Image size 1659x2212, CFP.
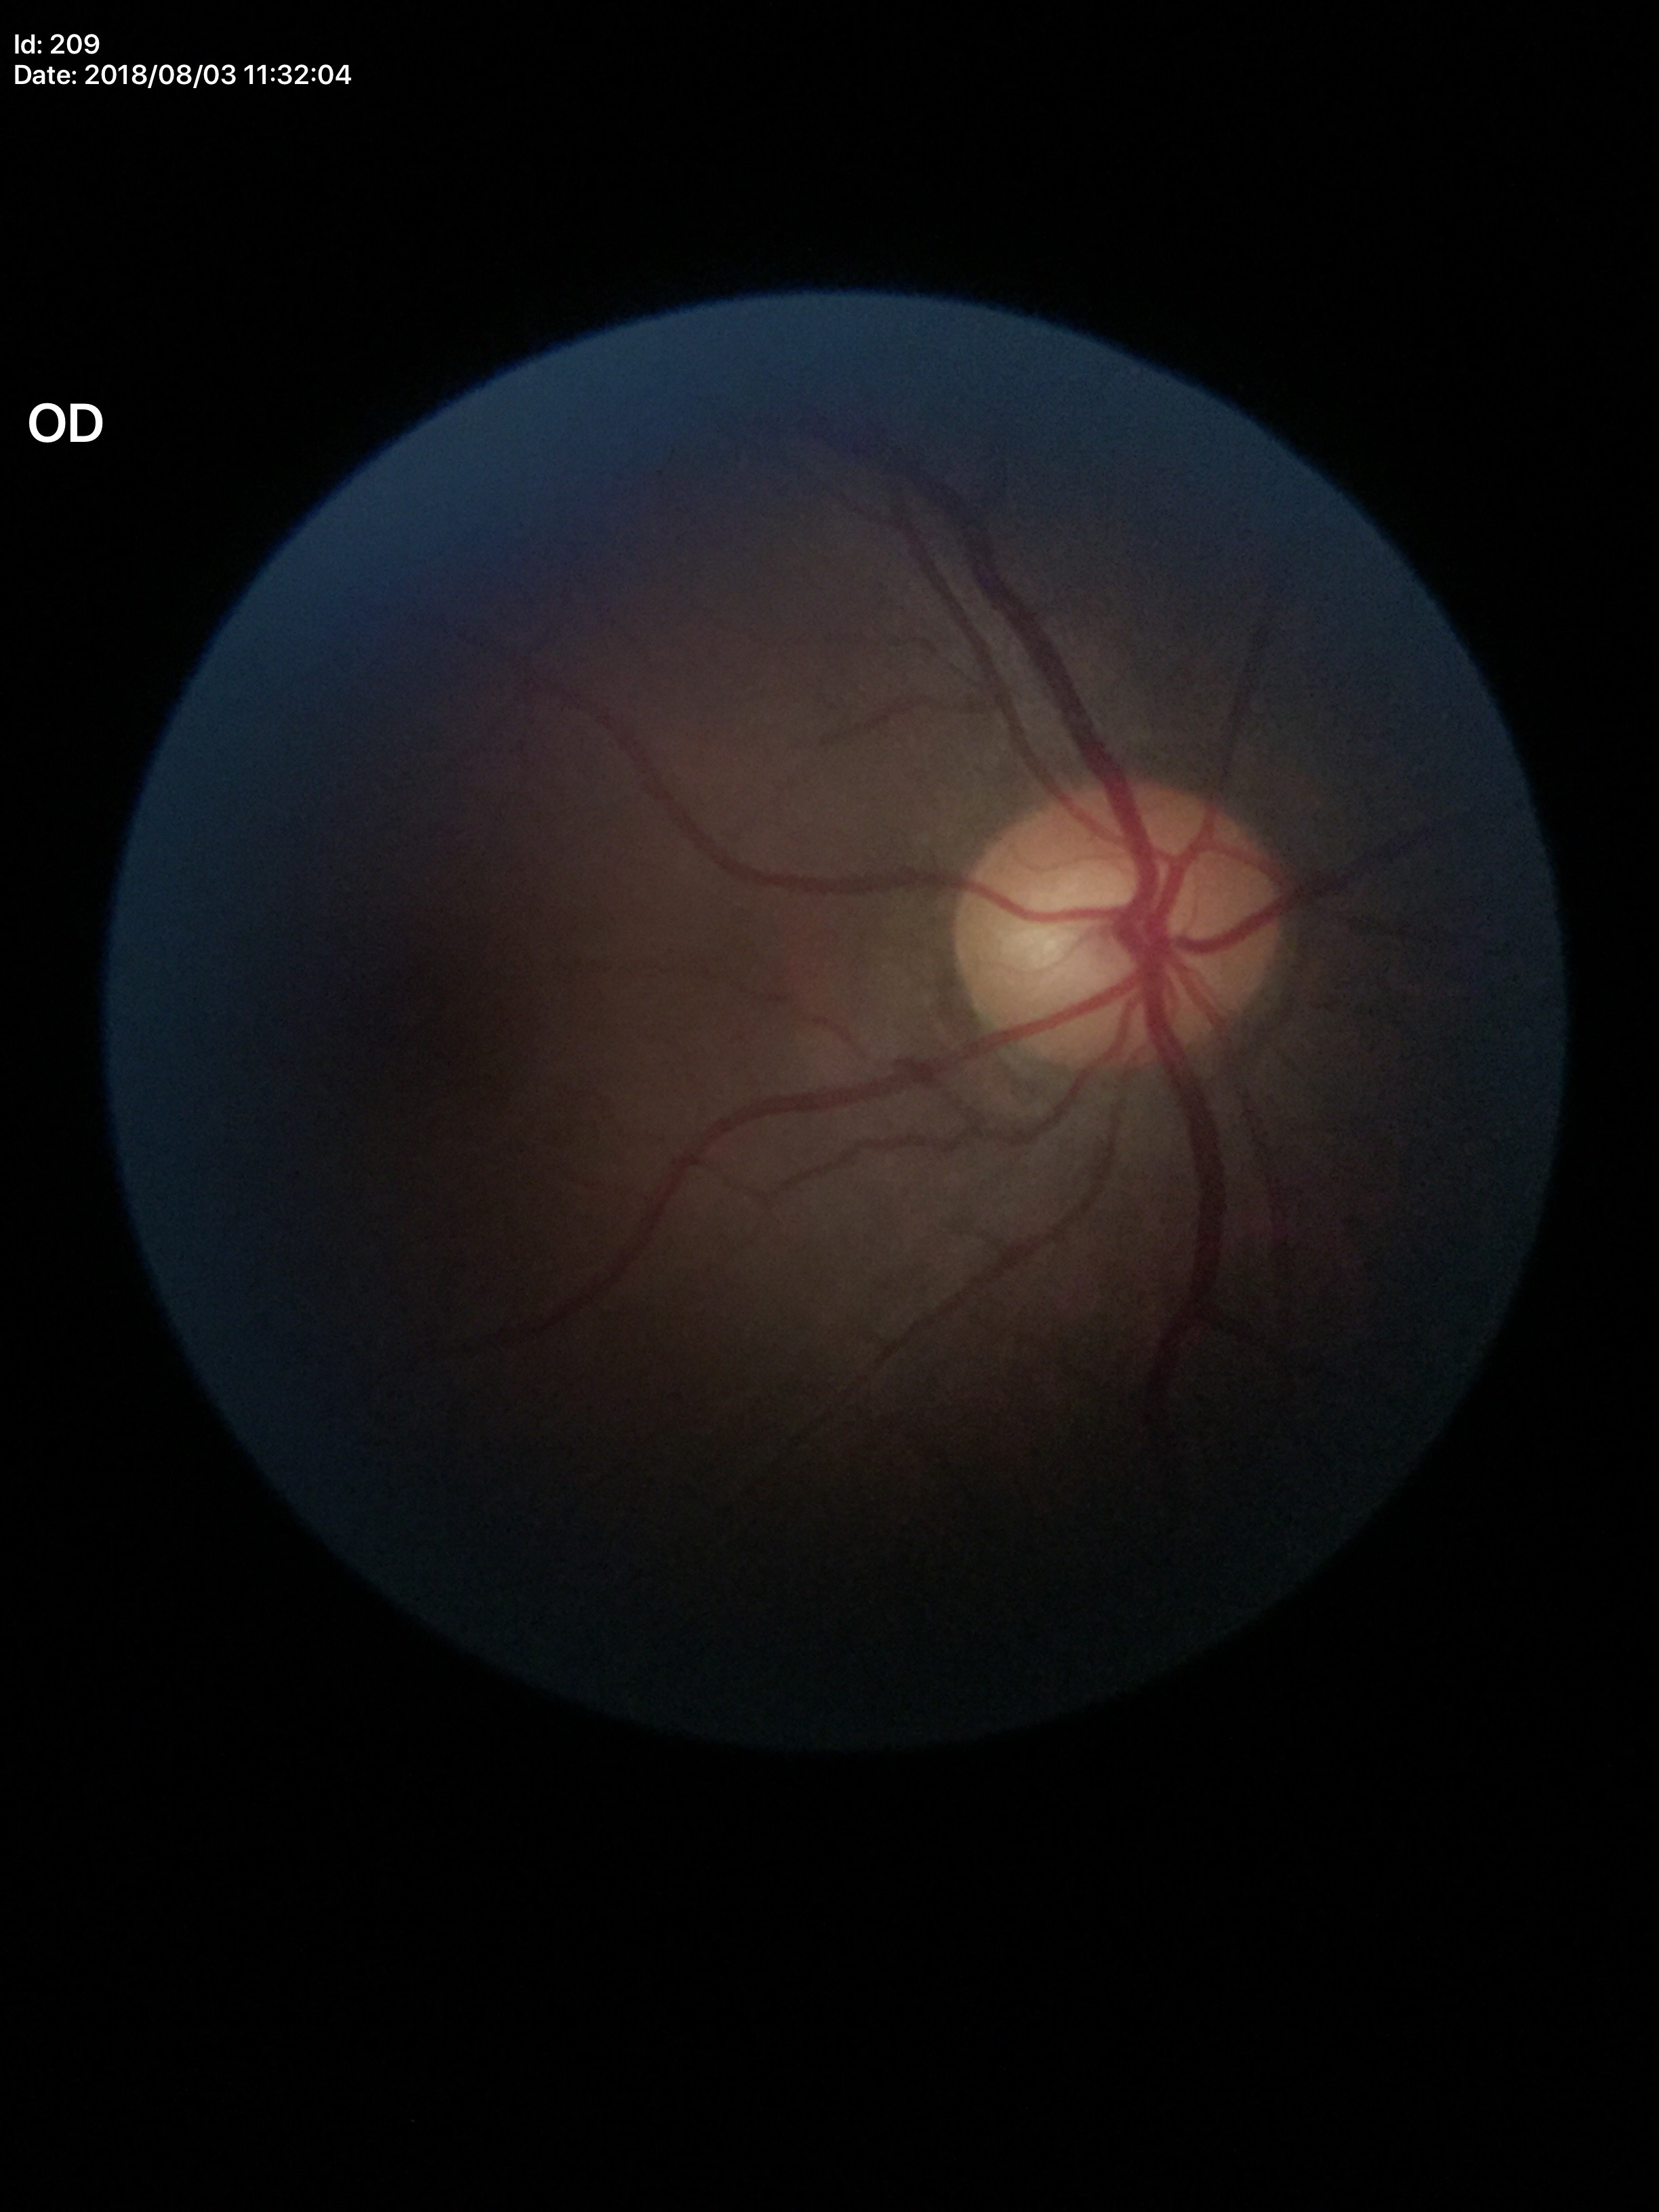
Vertical cup-disc ratio (VCDR) of 0.54. No evidence of glaucoma (unanimous normal call).